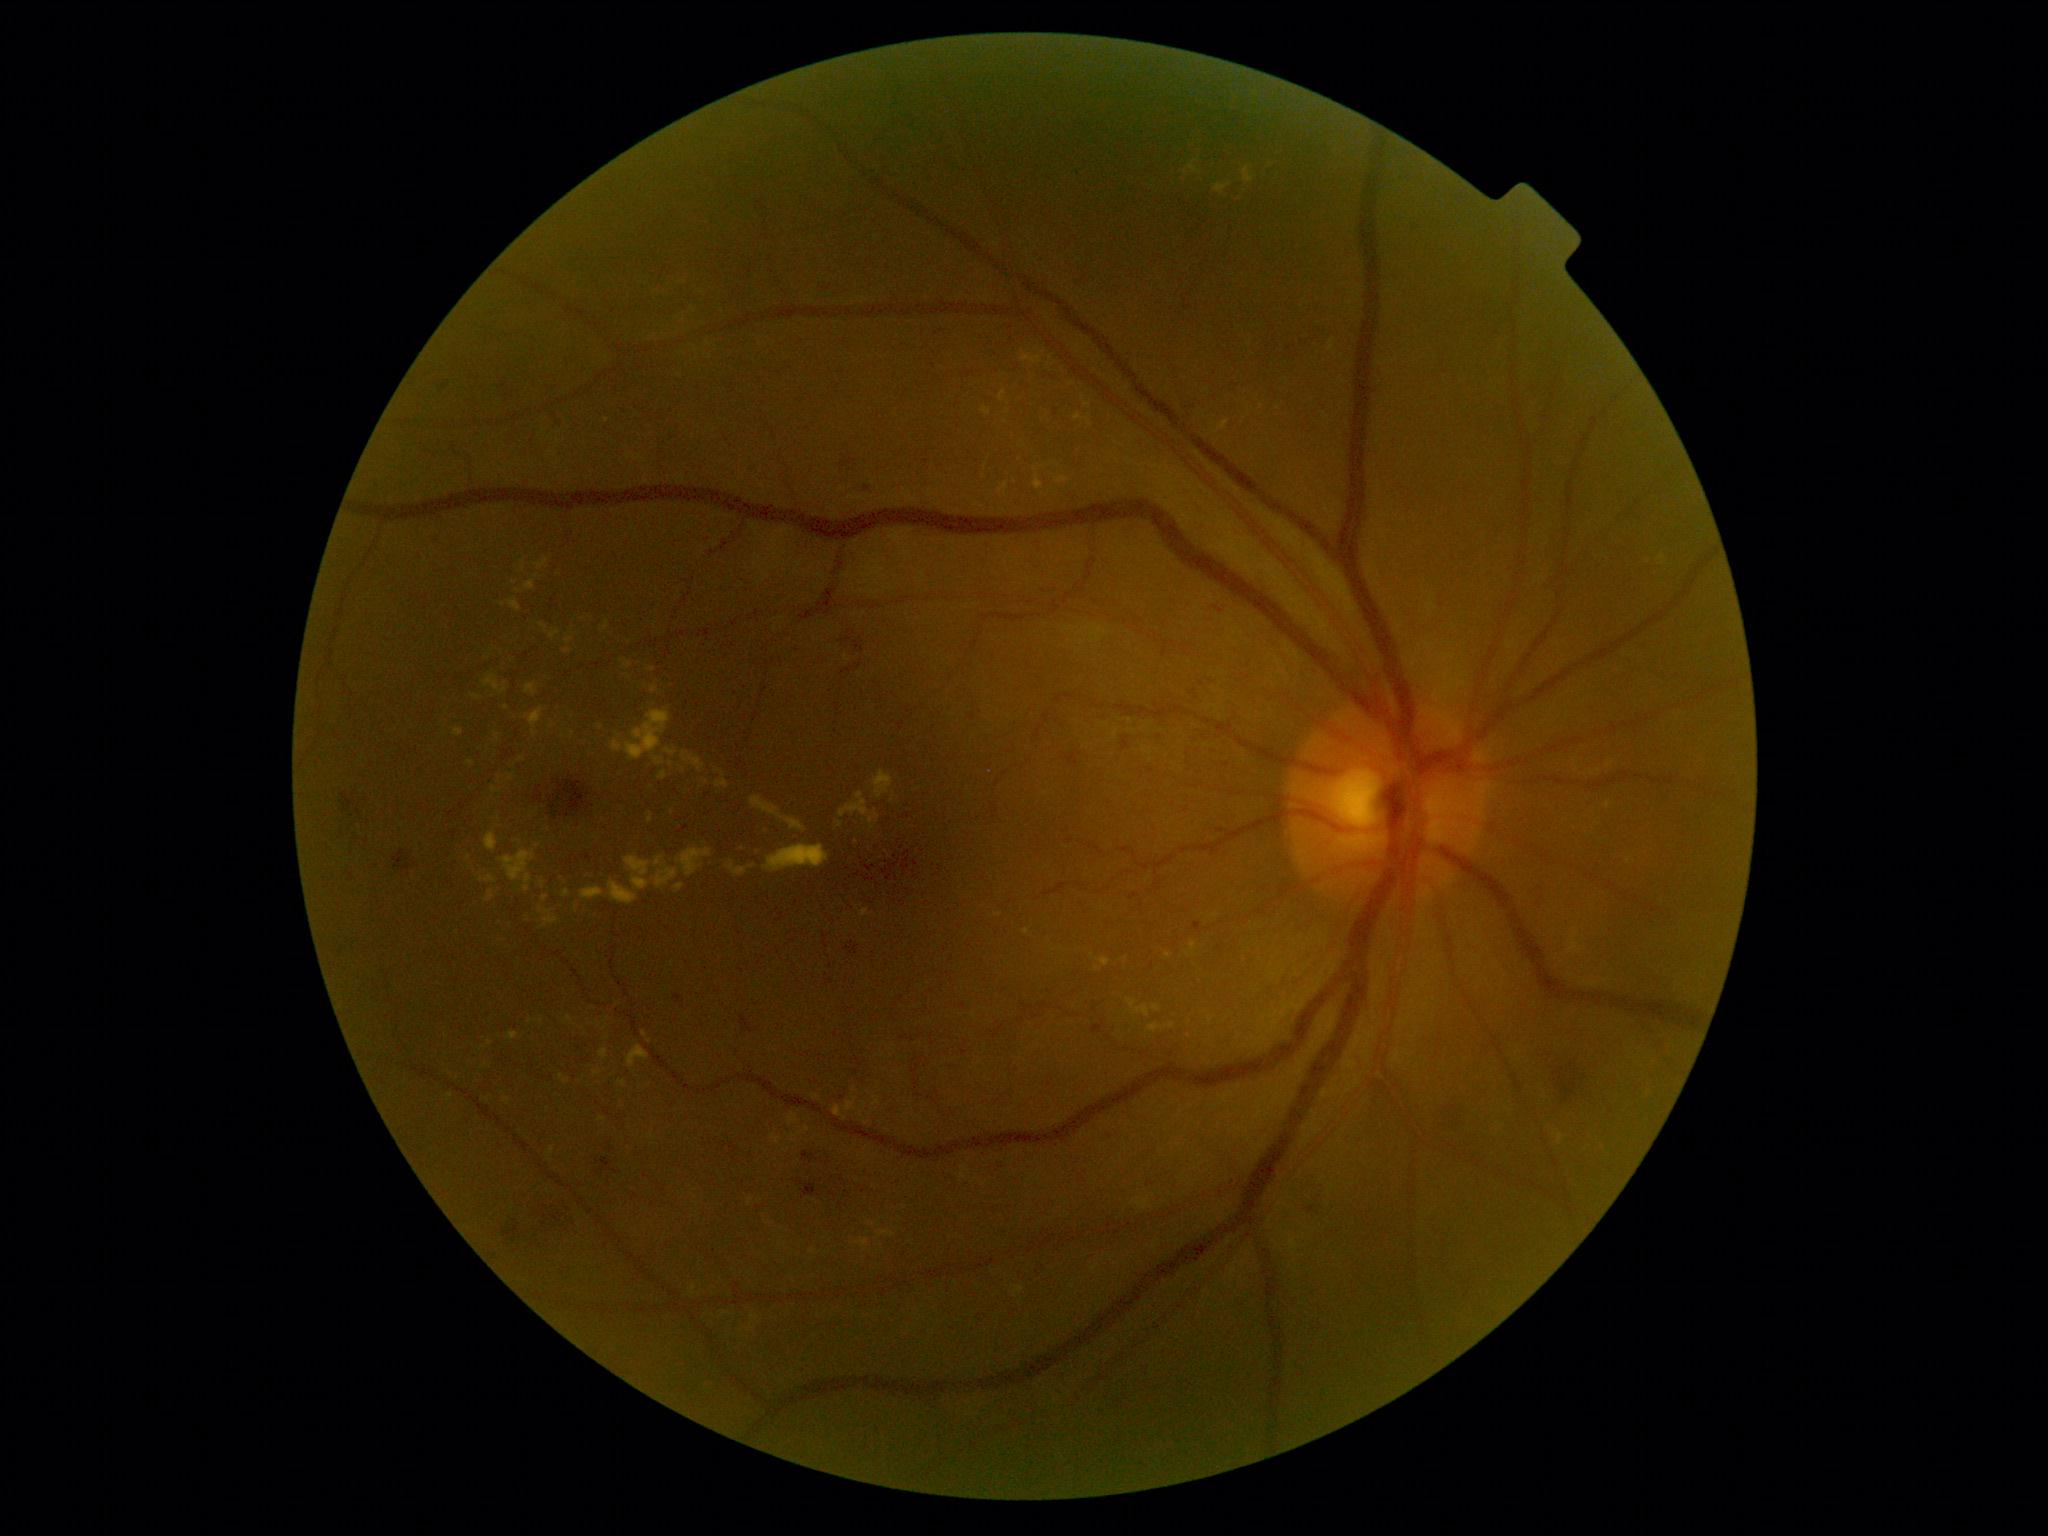

Diabetic retinopathy (DR): grade 2
Lesions identified (partial list):
hard exudates (EXs) (more not shown): (472,694,482,700); (1034,465,1045,473); (625,855,651,891); (601,620,610,632); (548,1147,555,1157); (479,875,496,884); (559,1074,571,1084); (564,649,572,654); (1135,1197,1150,1210); (683,752,706,772)
Smaller EXs around [816, 1097]; [672, 811]; [622, 661]; [512, 776]; [672, 764]; [1262, 407]; [998, 916]